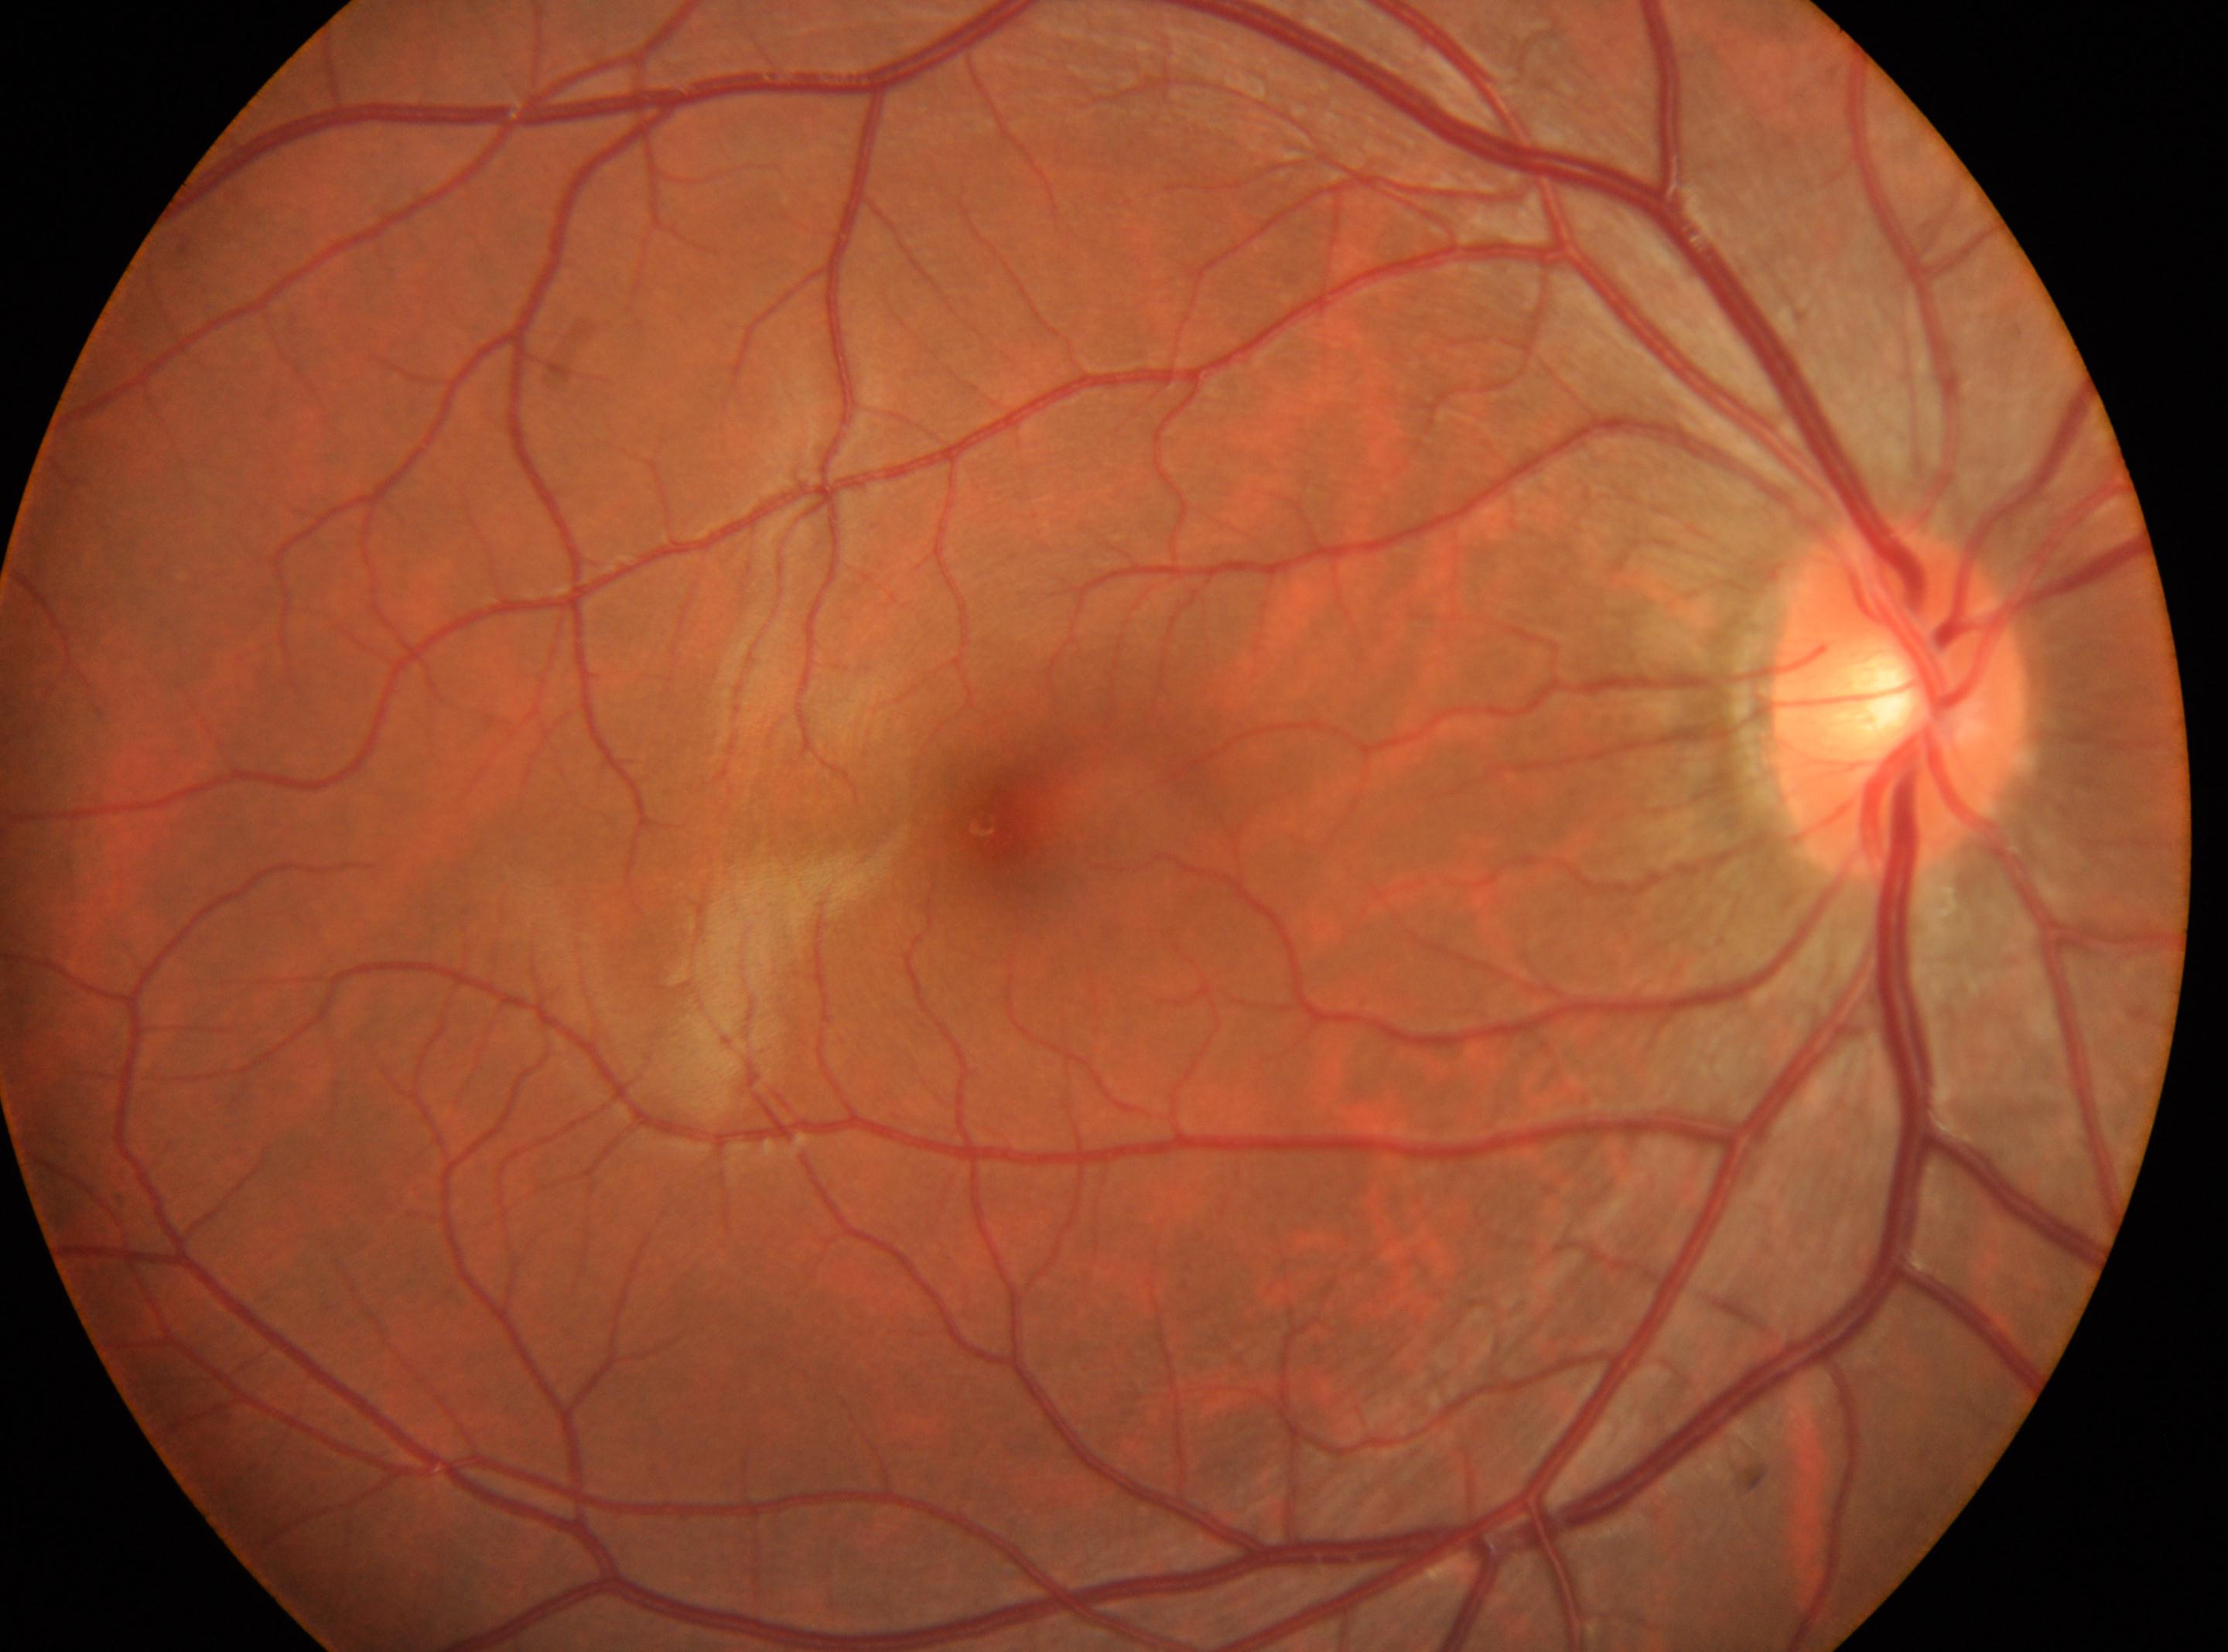 Optic disc located at (x: 1898, y: 701).
DR: grade 0.
Fovea center: (x: 996, y: 821).
Eye: OD.